45° FOV:
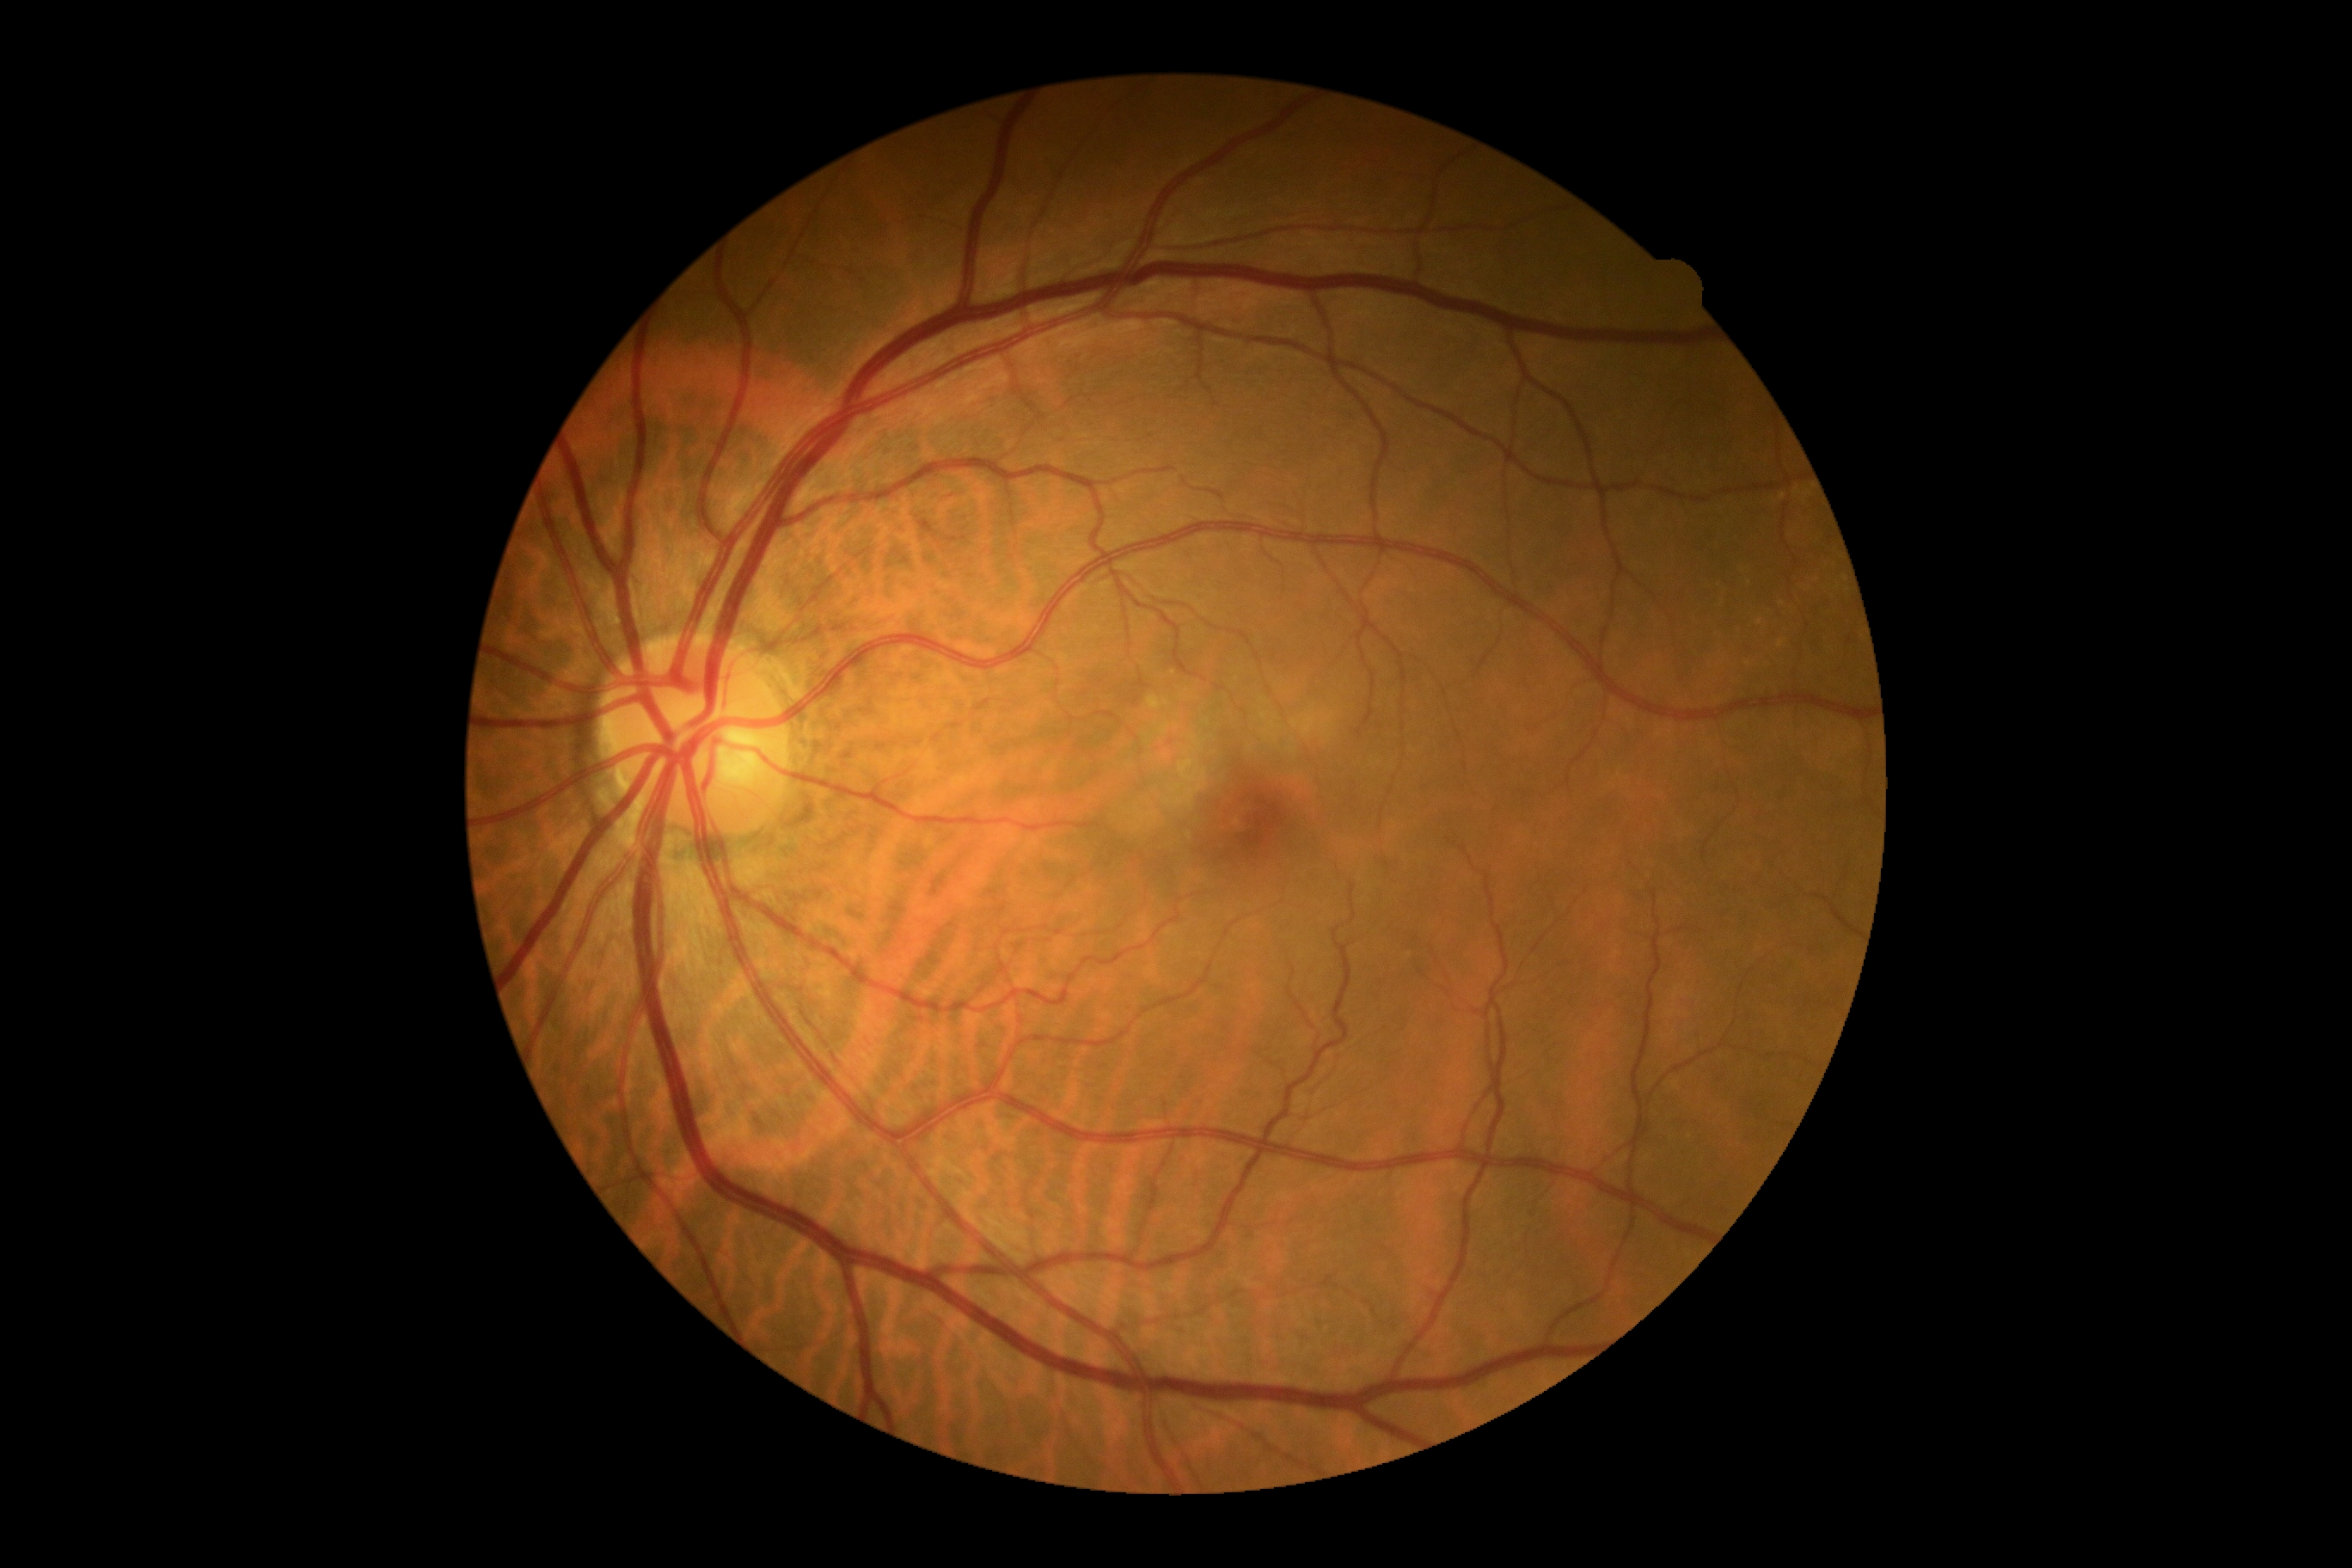

{
  "dr_grade": "0"
}